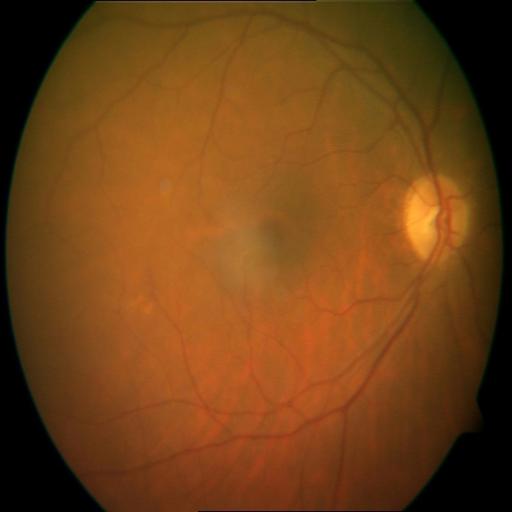

Retinal fundus photograph demonstrating cystoid macular edema.